Non-mydriatic.
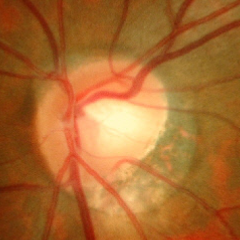
Glaucoma assessment = early glaucomatous optic neuropathy.